130° field of view (Natus RetCam Envision); 1440 by 1080 pixels; pediatric retinal photograph (wide-field): 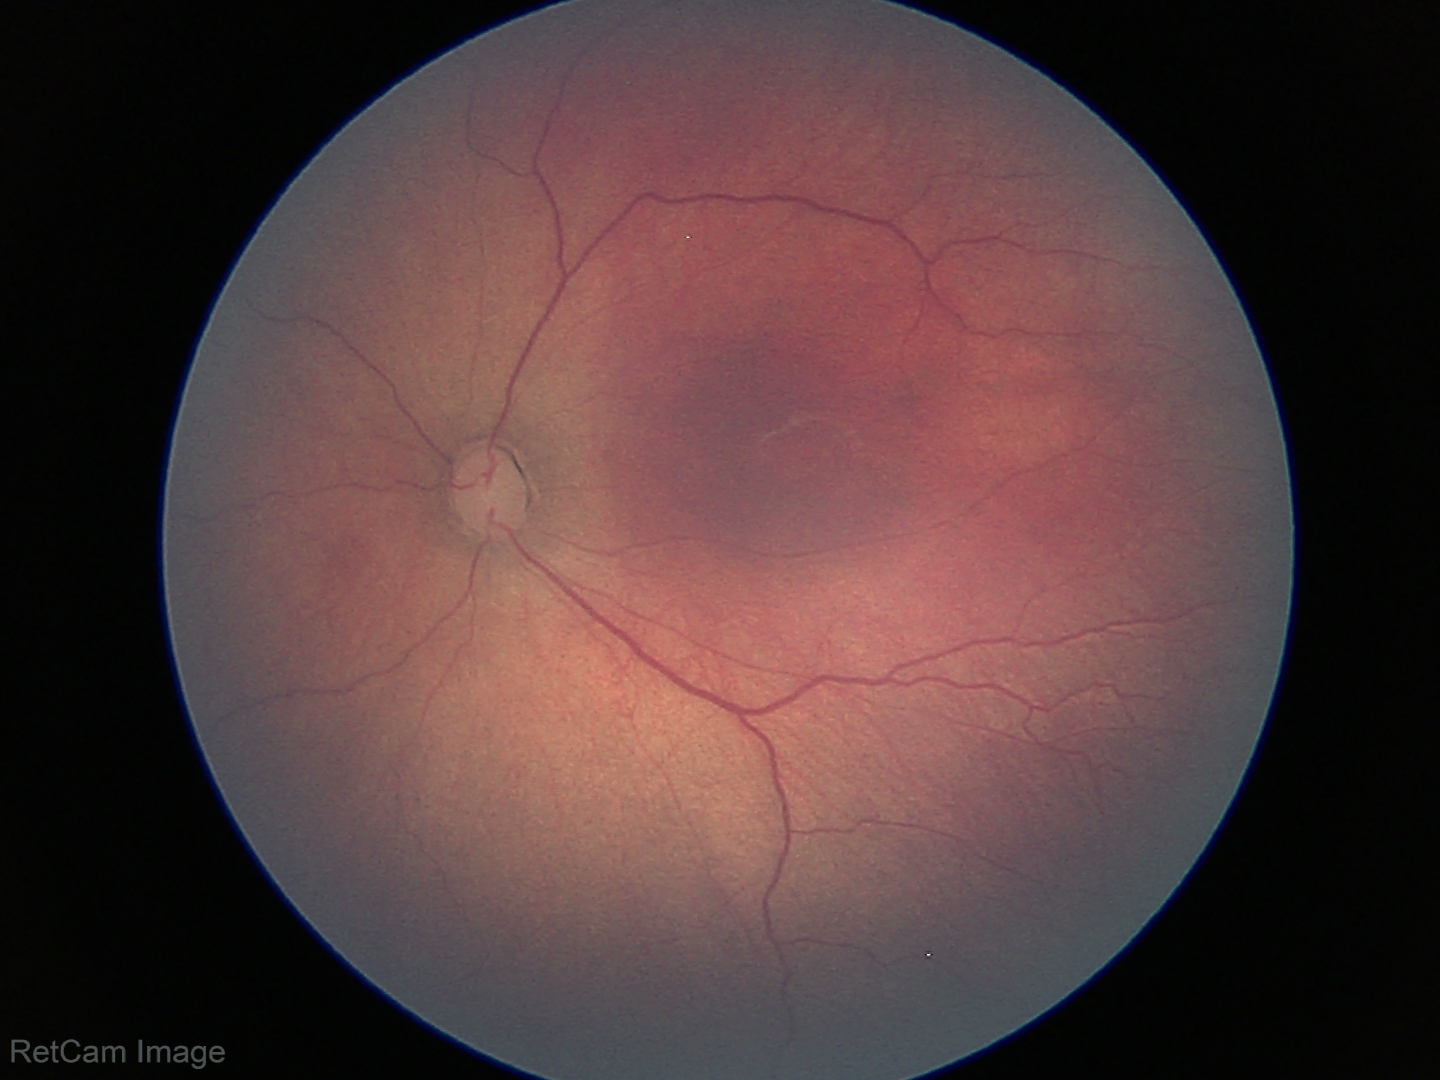

Screening: retinopathy of prematurity stage 3 | no plus disease — posterior pole vessels without abnormal dilation or tortuosity.